45° field of view, 2048x1536, color fundus photograph: 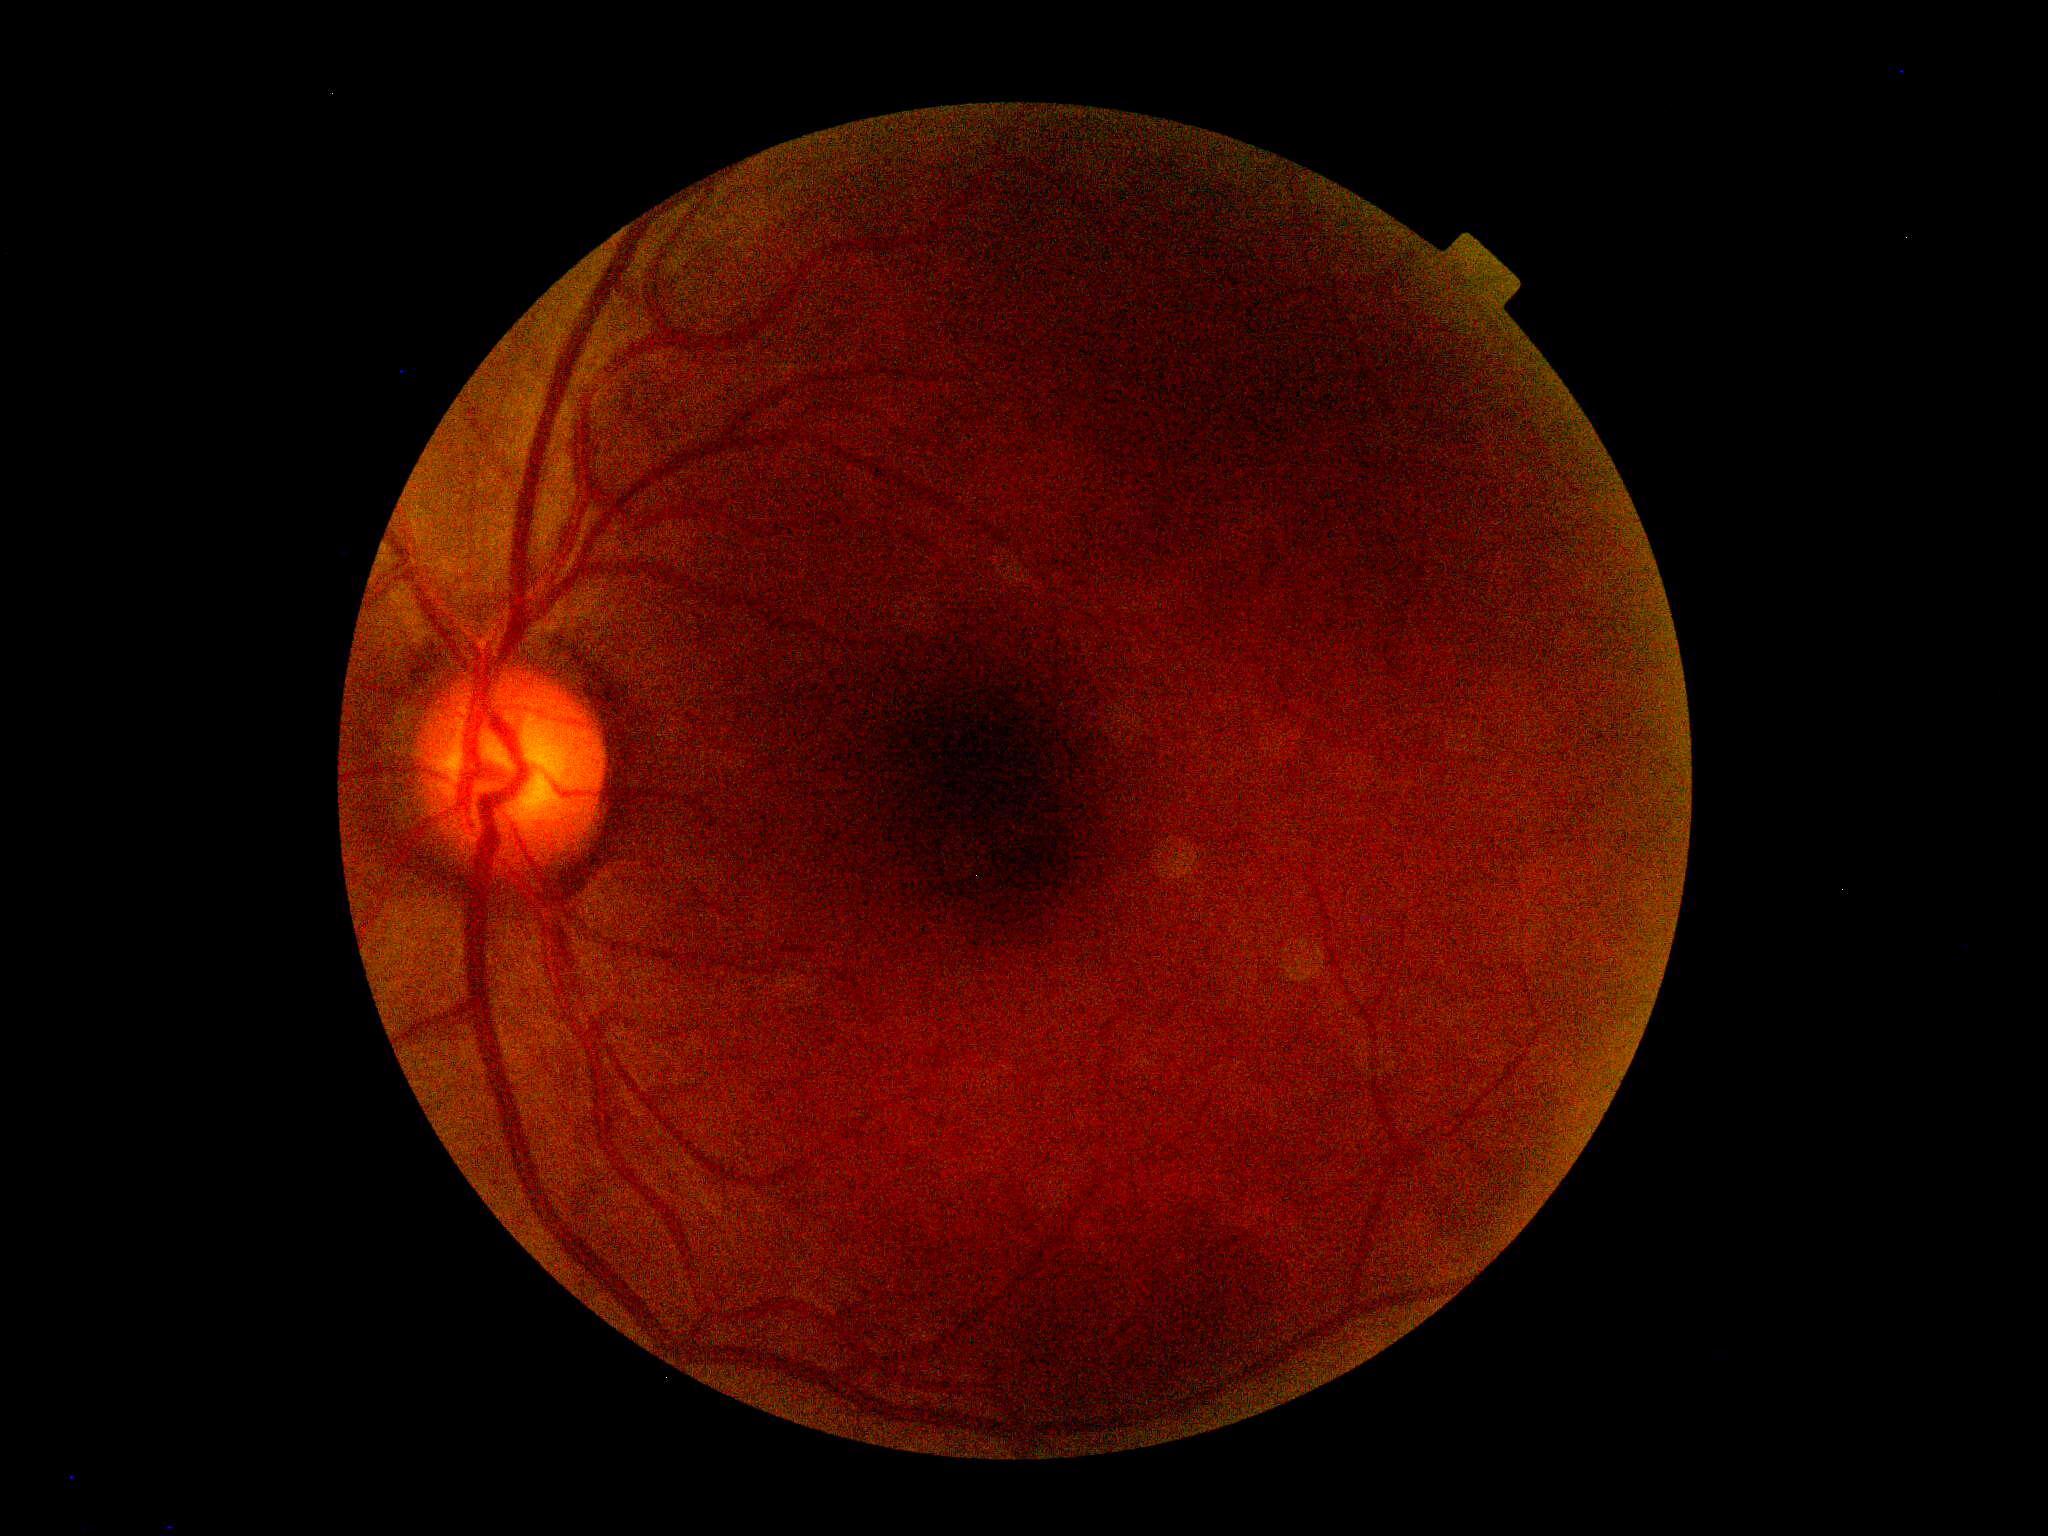 Diabetic retinopathy: grade 0.